Wide-field fundus photograph of an infant.
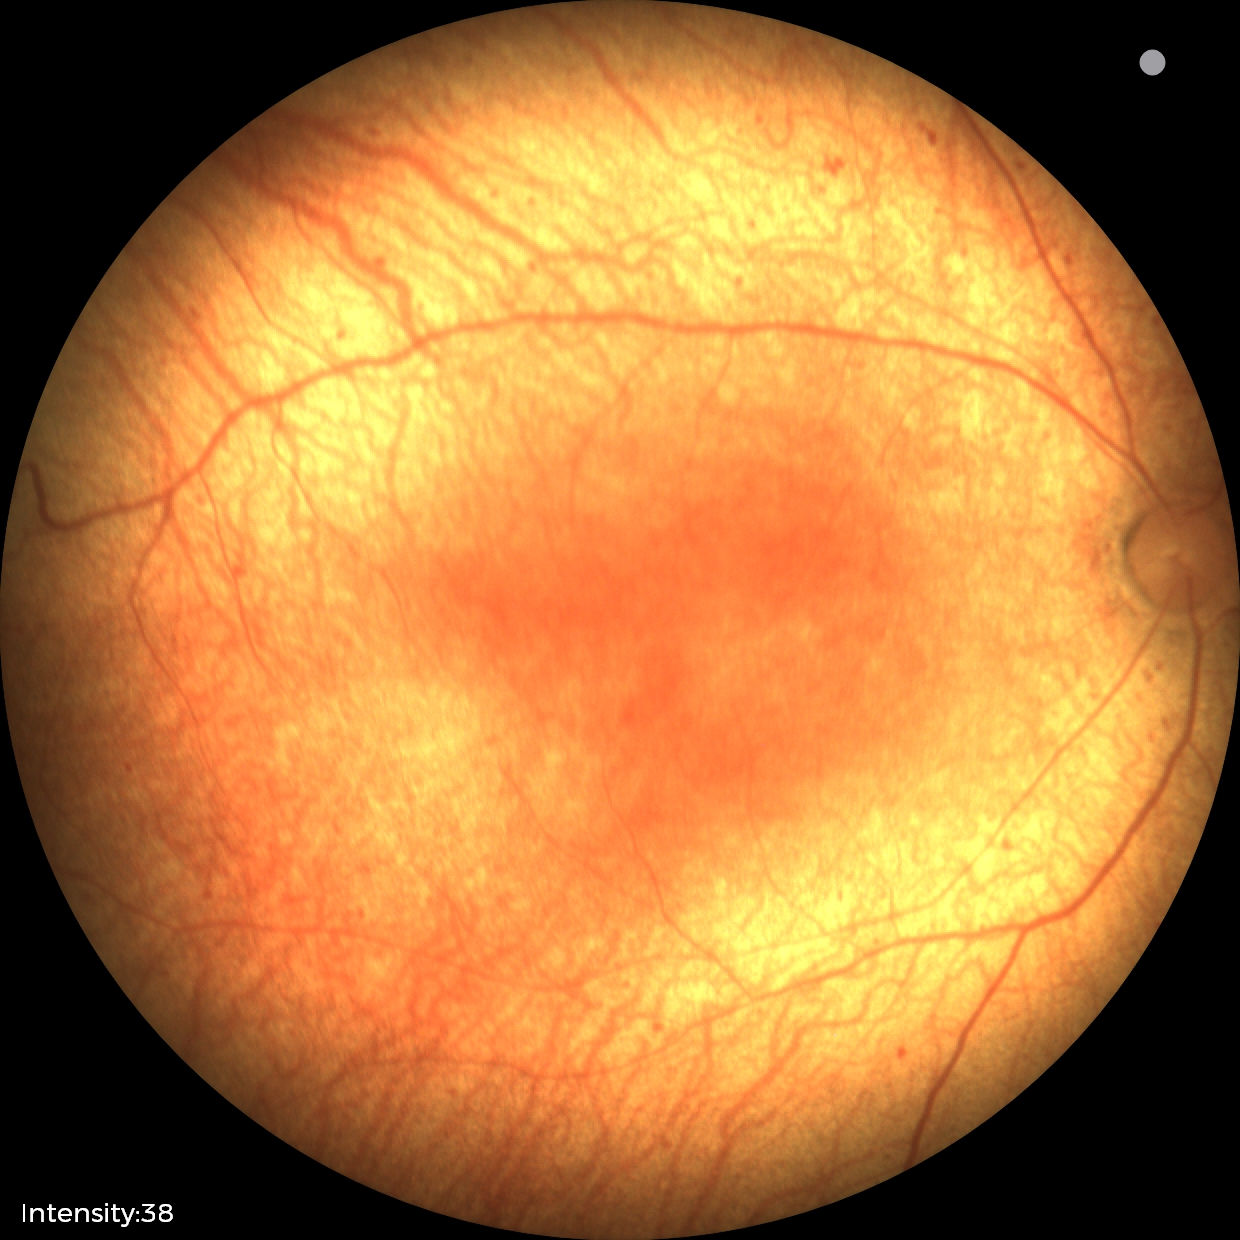 Series diagnosed as status post ROP. No plus disease.